FOV: 45 degrees:
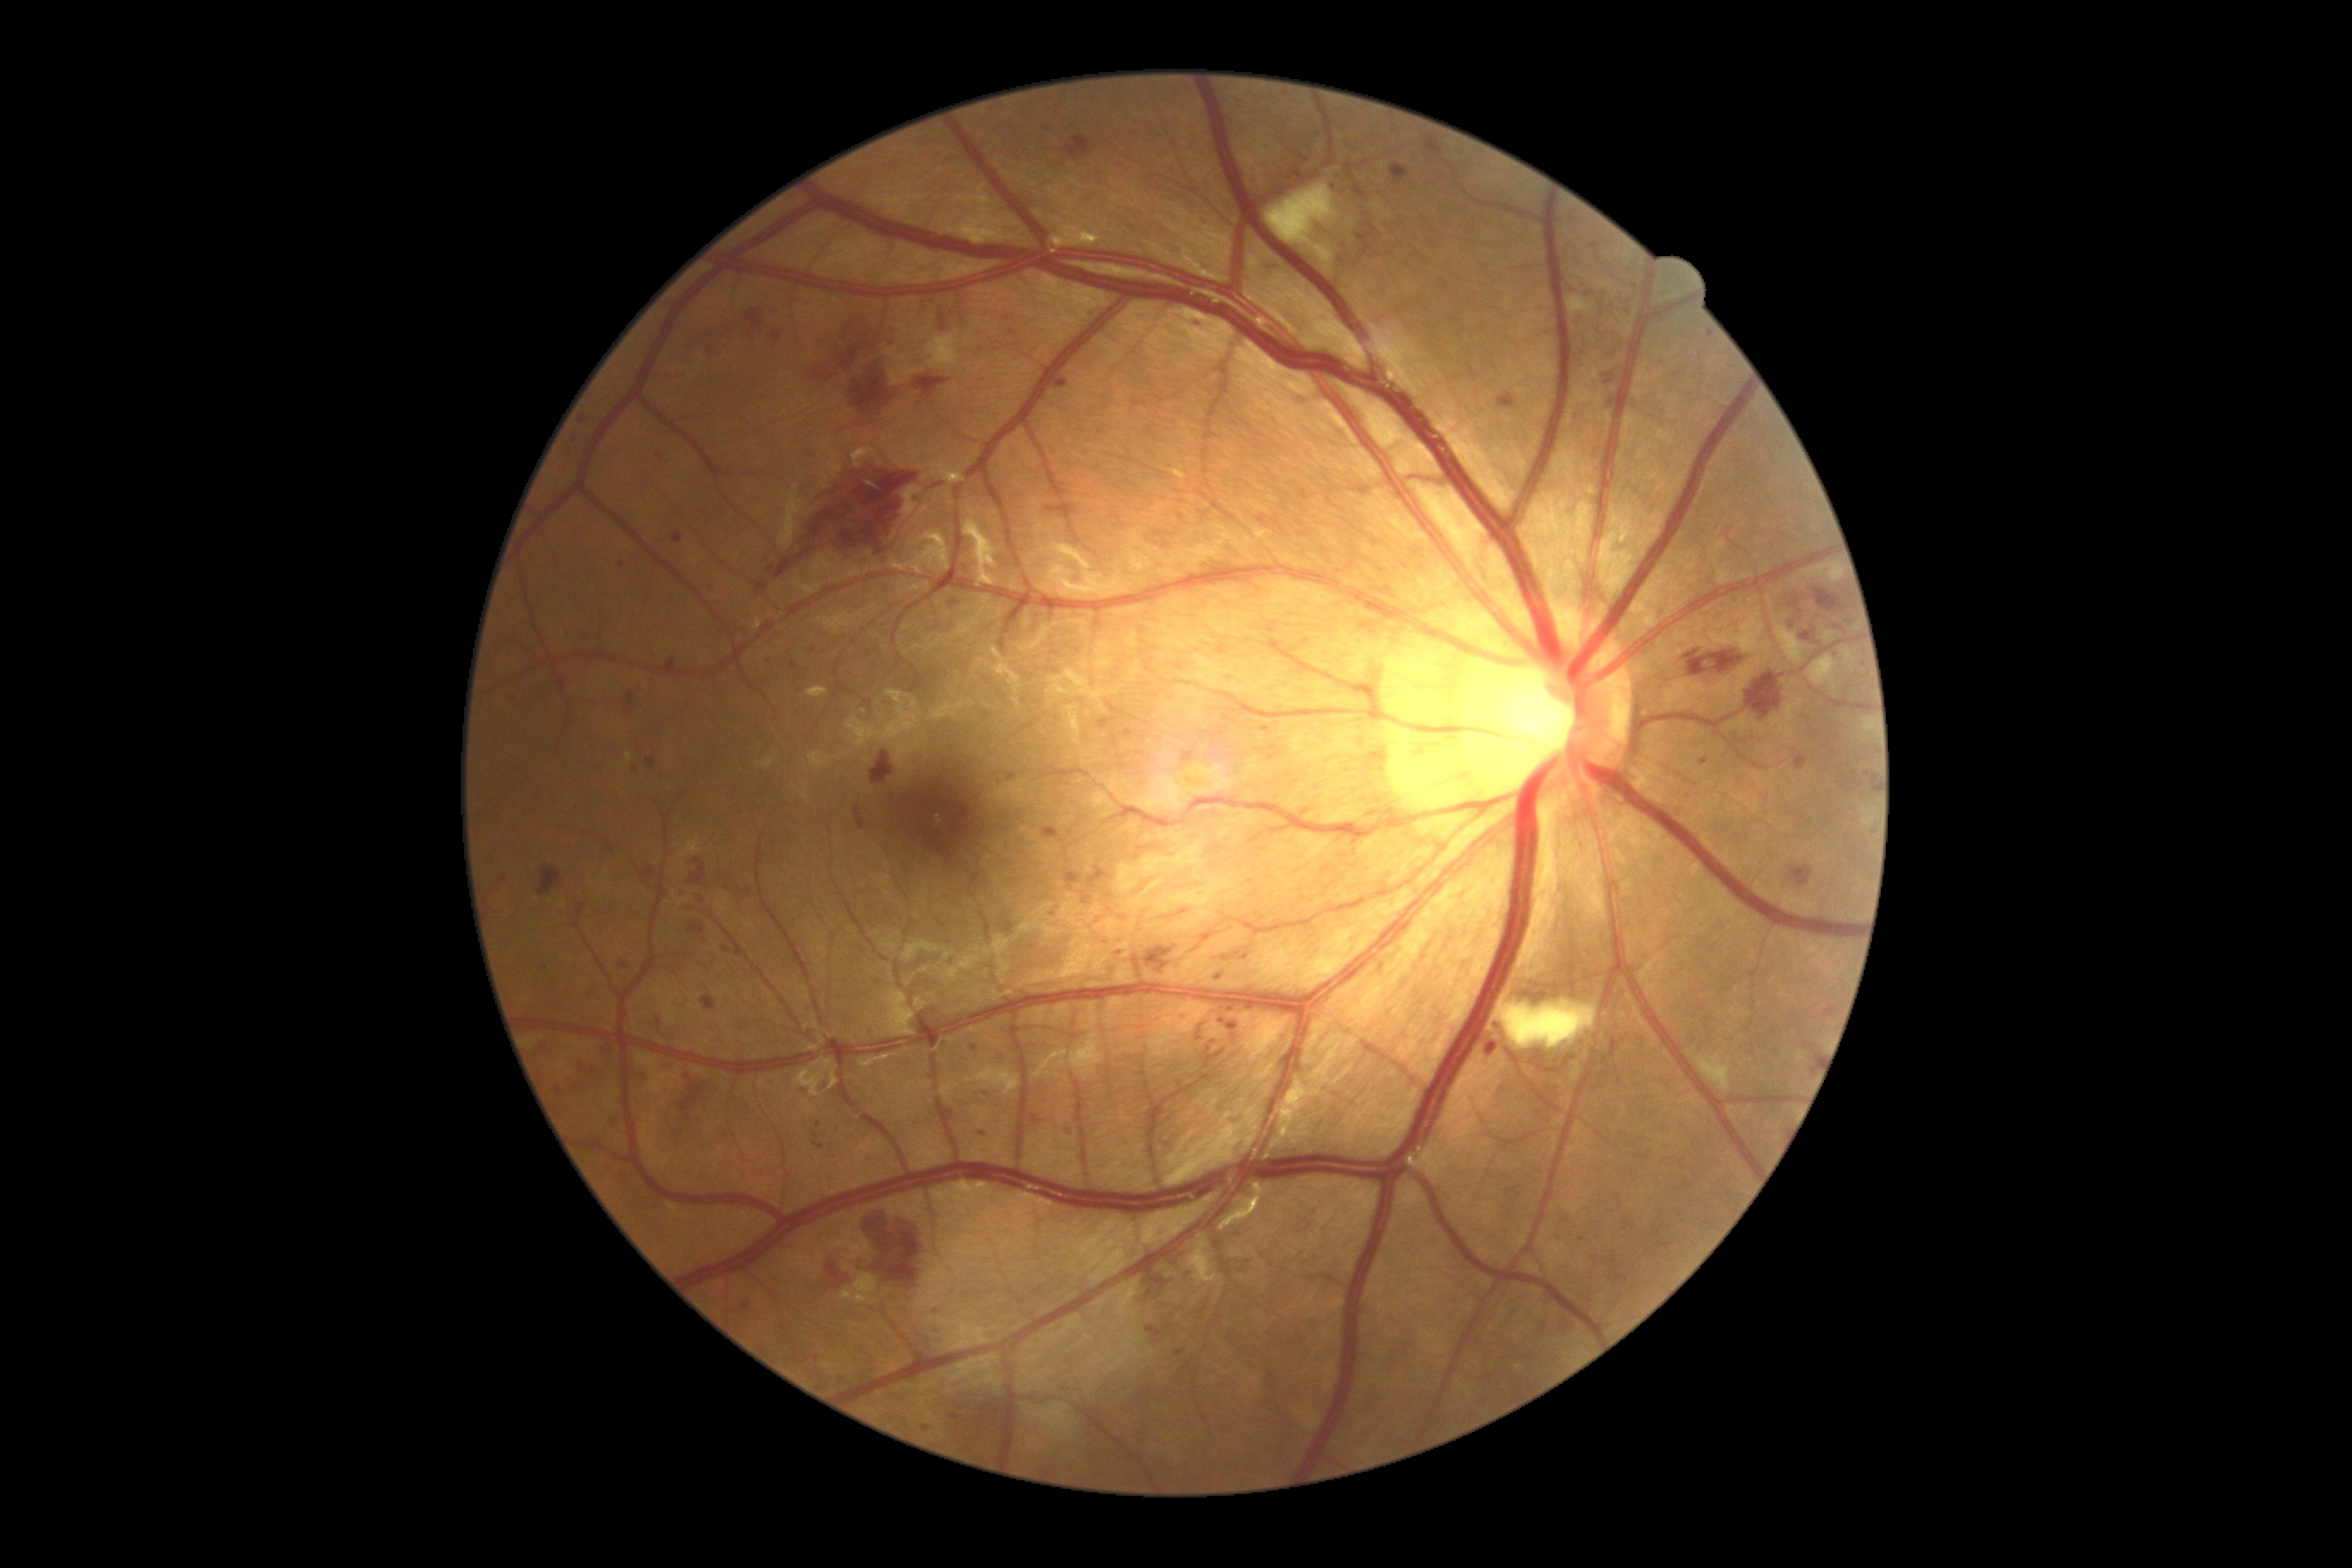

Diabetic retinopathy (DR): grade 3
Representative lesions:
soft exudates (SEs): Rect(1775, 623, 1806, 665), Rect(1863, 720, 1875, 733), Rect(1861, 807, 1877, 828), Rect(1497, 1001, 1598, 1050), Rect(1808, 656, 1837, 687), Rect(1828, 561, 1844, 585), Rect(1266, 181, 1338, 269), Rect(926, 334, 960, 369), Rect(1700, 1067, 1736, 1094)
microaneurysms (MAs) (more not shown): Rect(1031, 1115, 1041, 1124), Rect(814, 1142, 824, 1149), Rect(673, 534, 683, 544), Rect(742, 1304, 750, 1311), Rect(1055, 376, 1070, 389), Rect(1192, 319, 1206, 333), Rect(1261, 726, 1270, 733), Rect(933, 1326, 941, 1335), Rect(922, 1424, 931, 1431)
Small MAs near [816,1136], [1582,1239], [768,664], [1596,246], [575,440], [1219,978], [1503,1091], [974,1049]
hemorrhages (HEs) (more not shown): Rect(807, 365, 836, 381), Rect(1682, 649, 1744, 677), Rect(1189, 319, 1208, 331), Rect(1390, 164, 1409, 185), Rect(1815, 589, 1846, 613), Rect(701, 996, 718, 1012), Rect(575, 900, 585, 919), Rect(601, 843, 615, 855), Rect(1082, 897, 1091, 903), Rect(733, 948, 742, 959), Rect(666, 652, 677, 668), Rect(680, 1086, 704, 1112), Rect(496, 874, 508, 886), Rect(685, 1077, 711, 1089), Rect(682, 333, 714, 360), Rect(768, 462, 919, 580), Rect(1297, 154, 1309, 164)
Small HEs near [1047,128], [639,750], [726,949]
hard exudates (EXs): none identified